848 x 848 pixels. Posterior pole color fundus photograph. 45° FOV. NIDEK AFC-230:
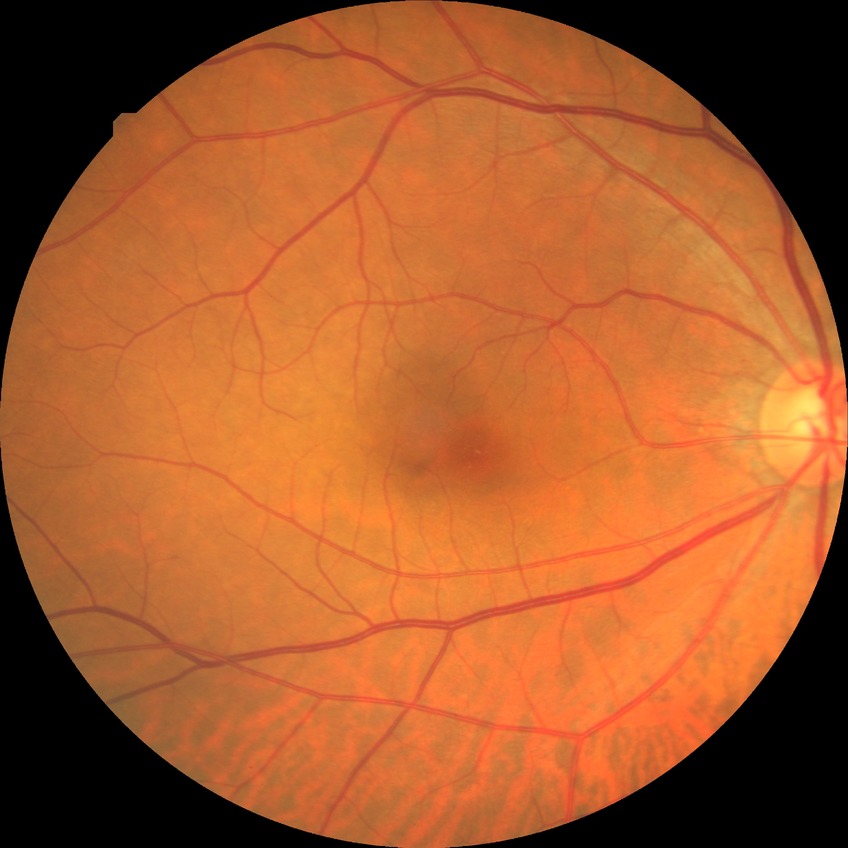

diabetic retinopathy grade: no diabetic retinopathy.